Posterior pole color fundus photograph.
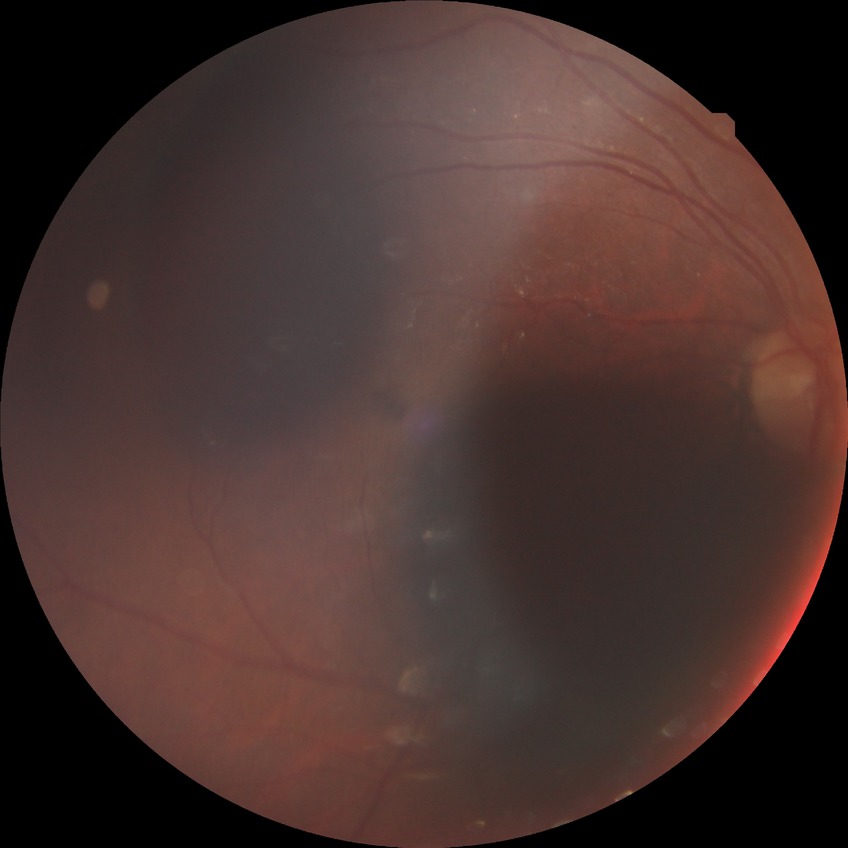
{"proliferative_class": "non-proliferative diabetic retinopathy", "davis_grade": "simple diabetic retinopathy (SDR)"}